Image size 1240x1240 · Phoenix ICON, 100° FOV · infant wide-field retinal image:
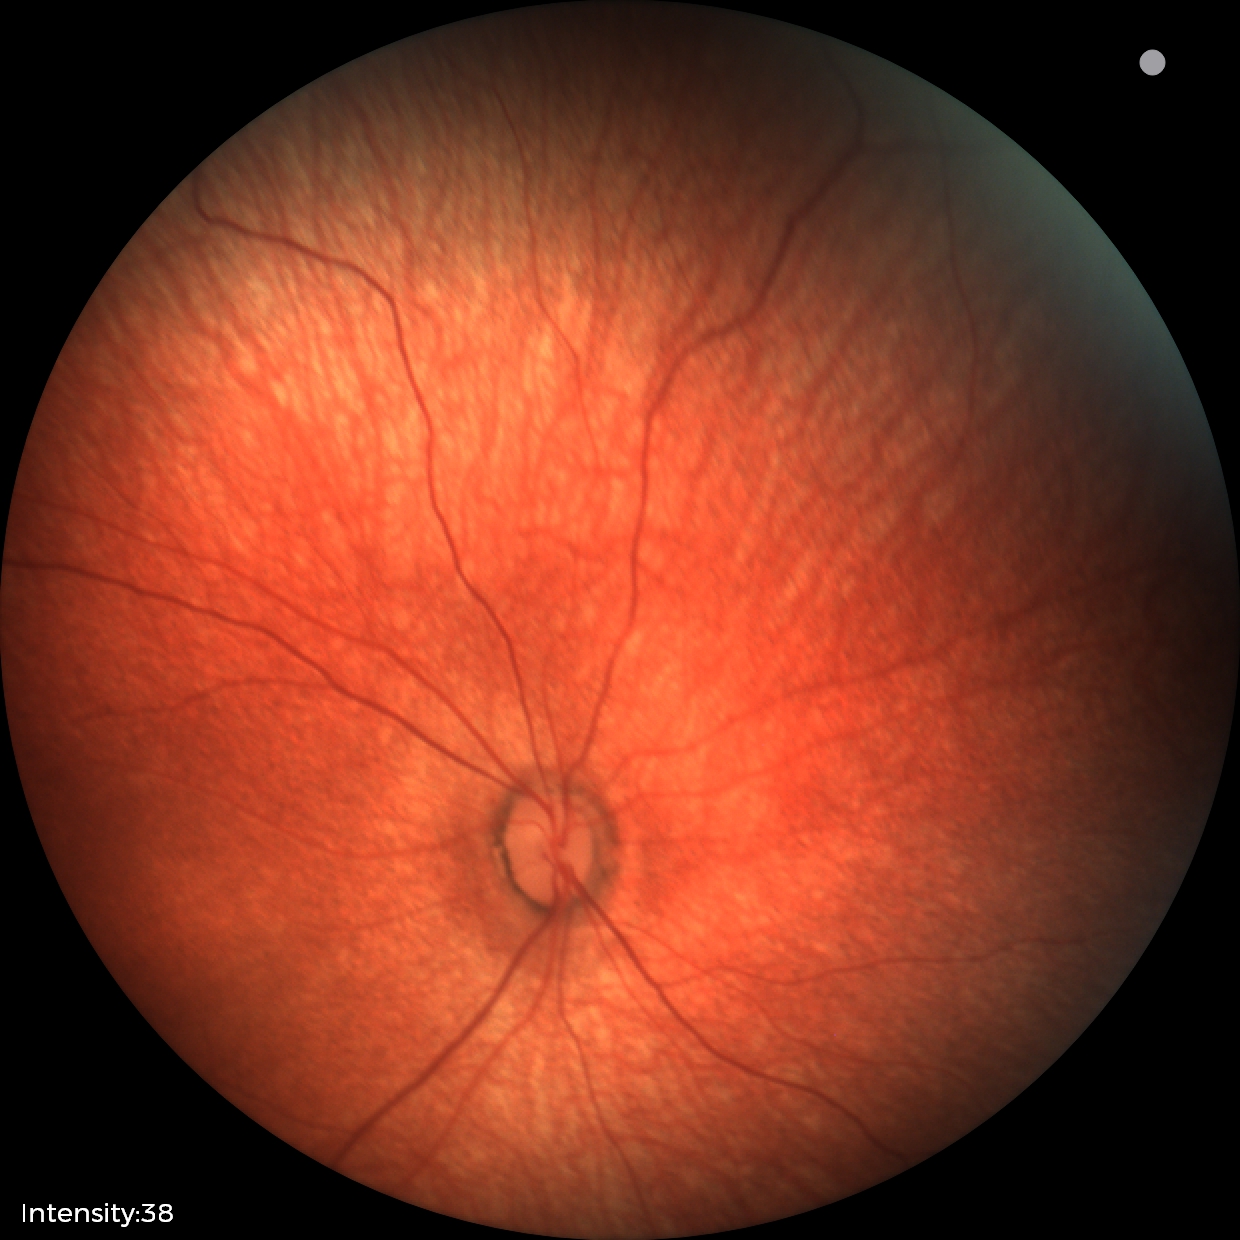

Normal screening examination.